Graded on the modified Davis scale; NIDEK AFC-230 fundus camera.
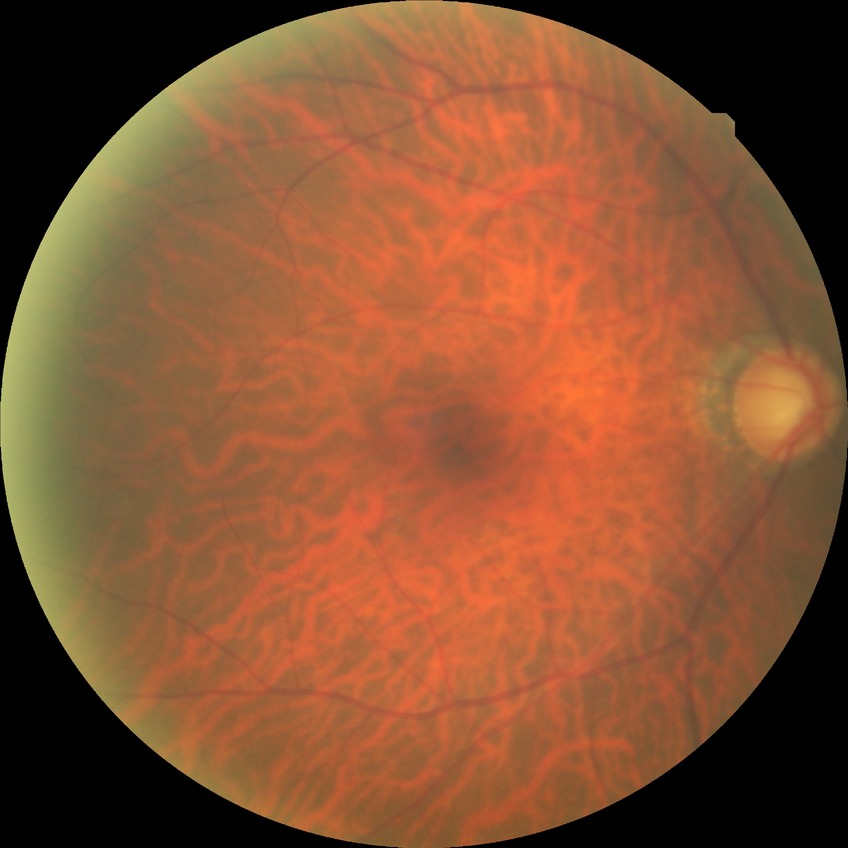
Diabetic retinopathy severity is no diabetic retinopathy.